45-degree field of view; graded on the modified Davis scale; NIDEK AFC-230 fundus camera.
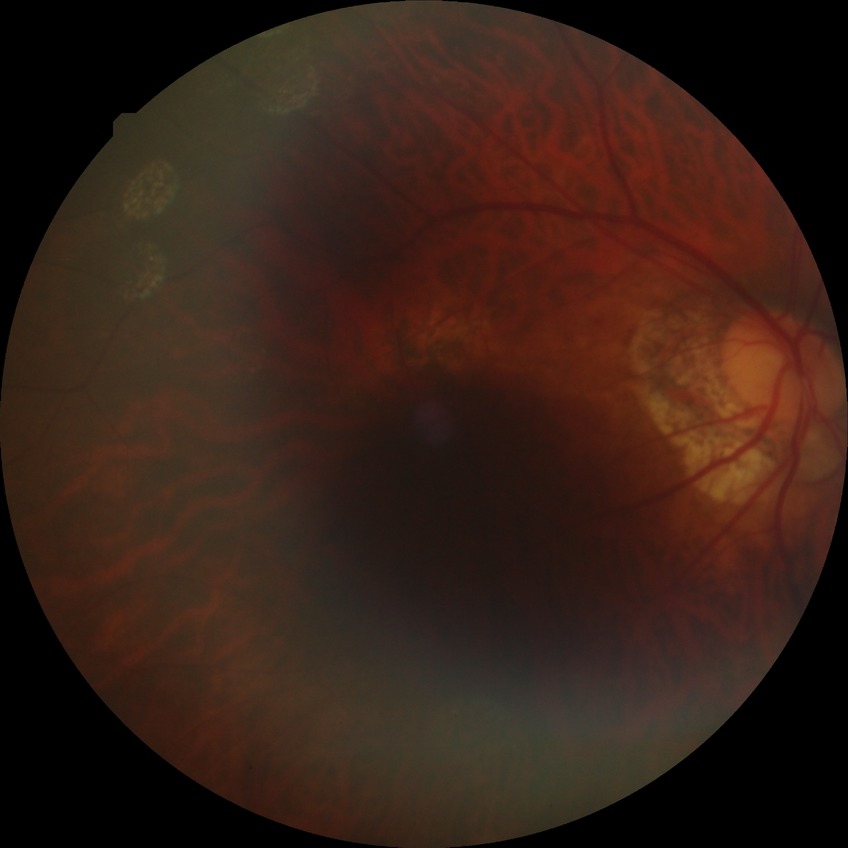

Disease class: non-proliferative diabetic retinopathy. Diabetic retinopathy (DR): SDR (simple diabetic retinopathy).